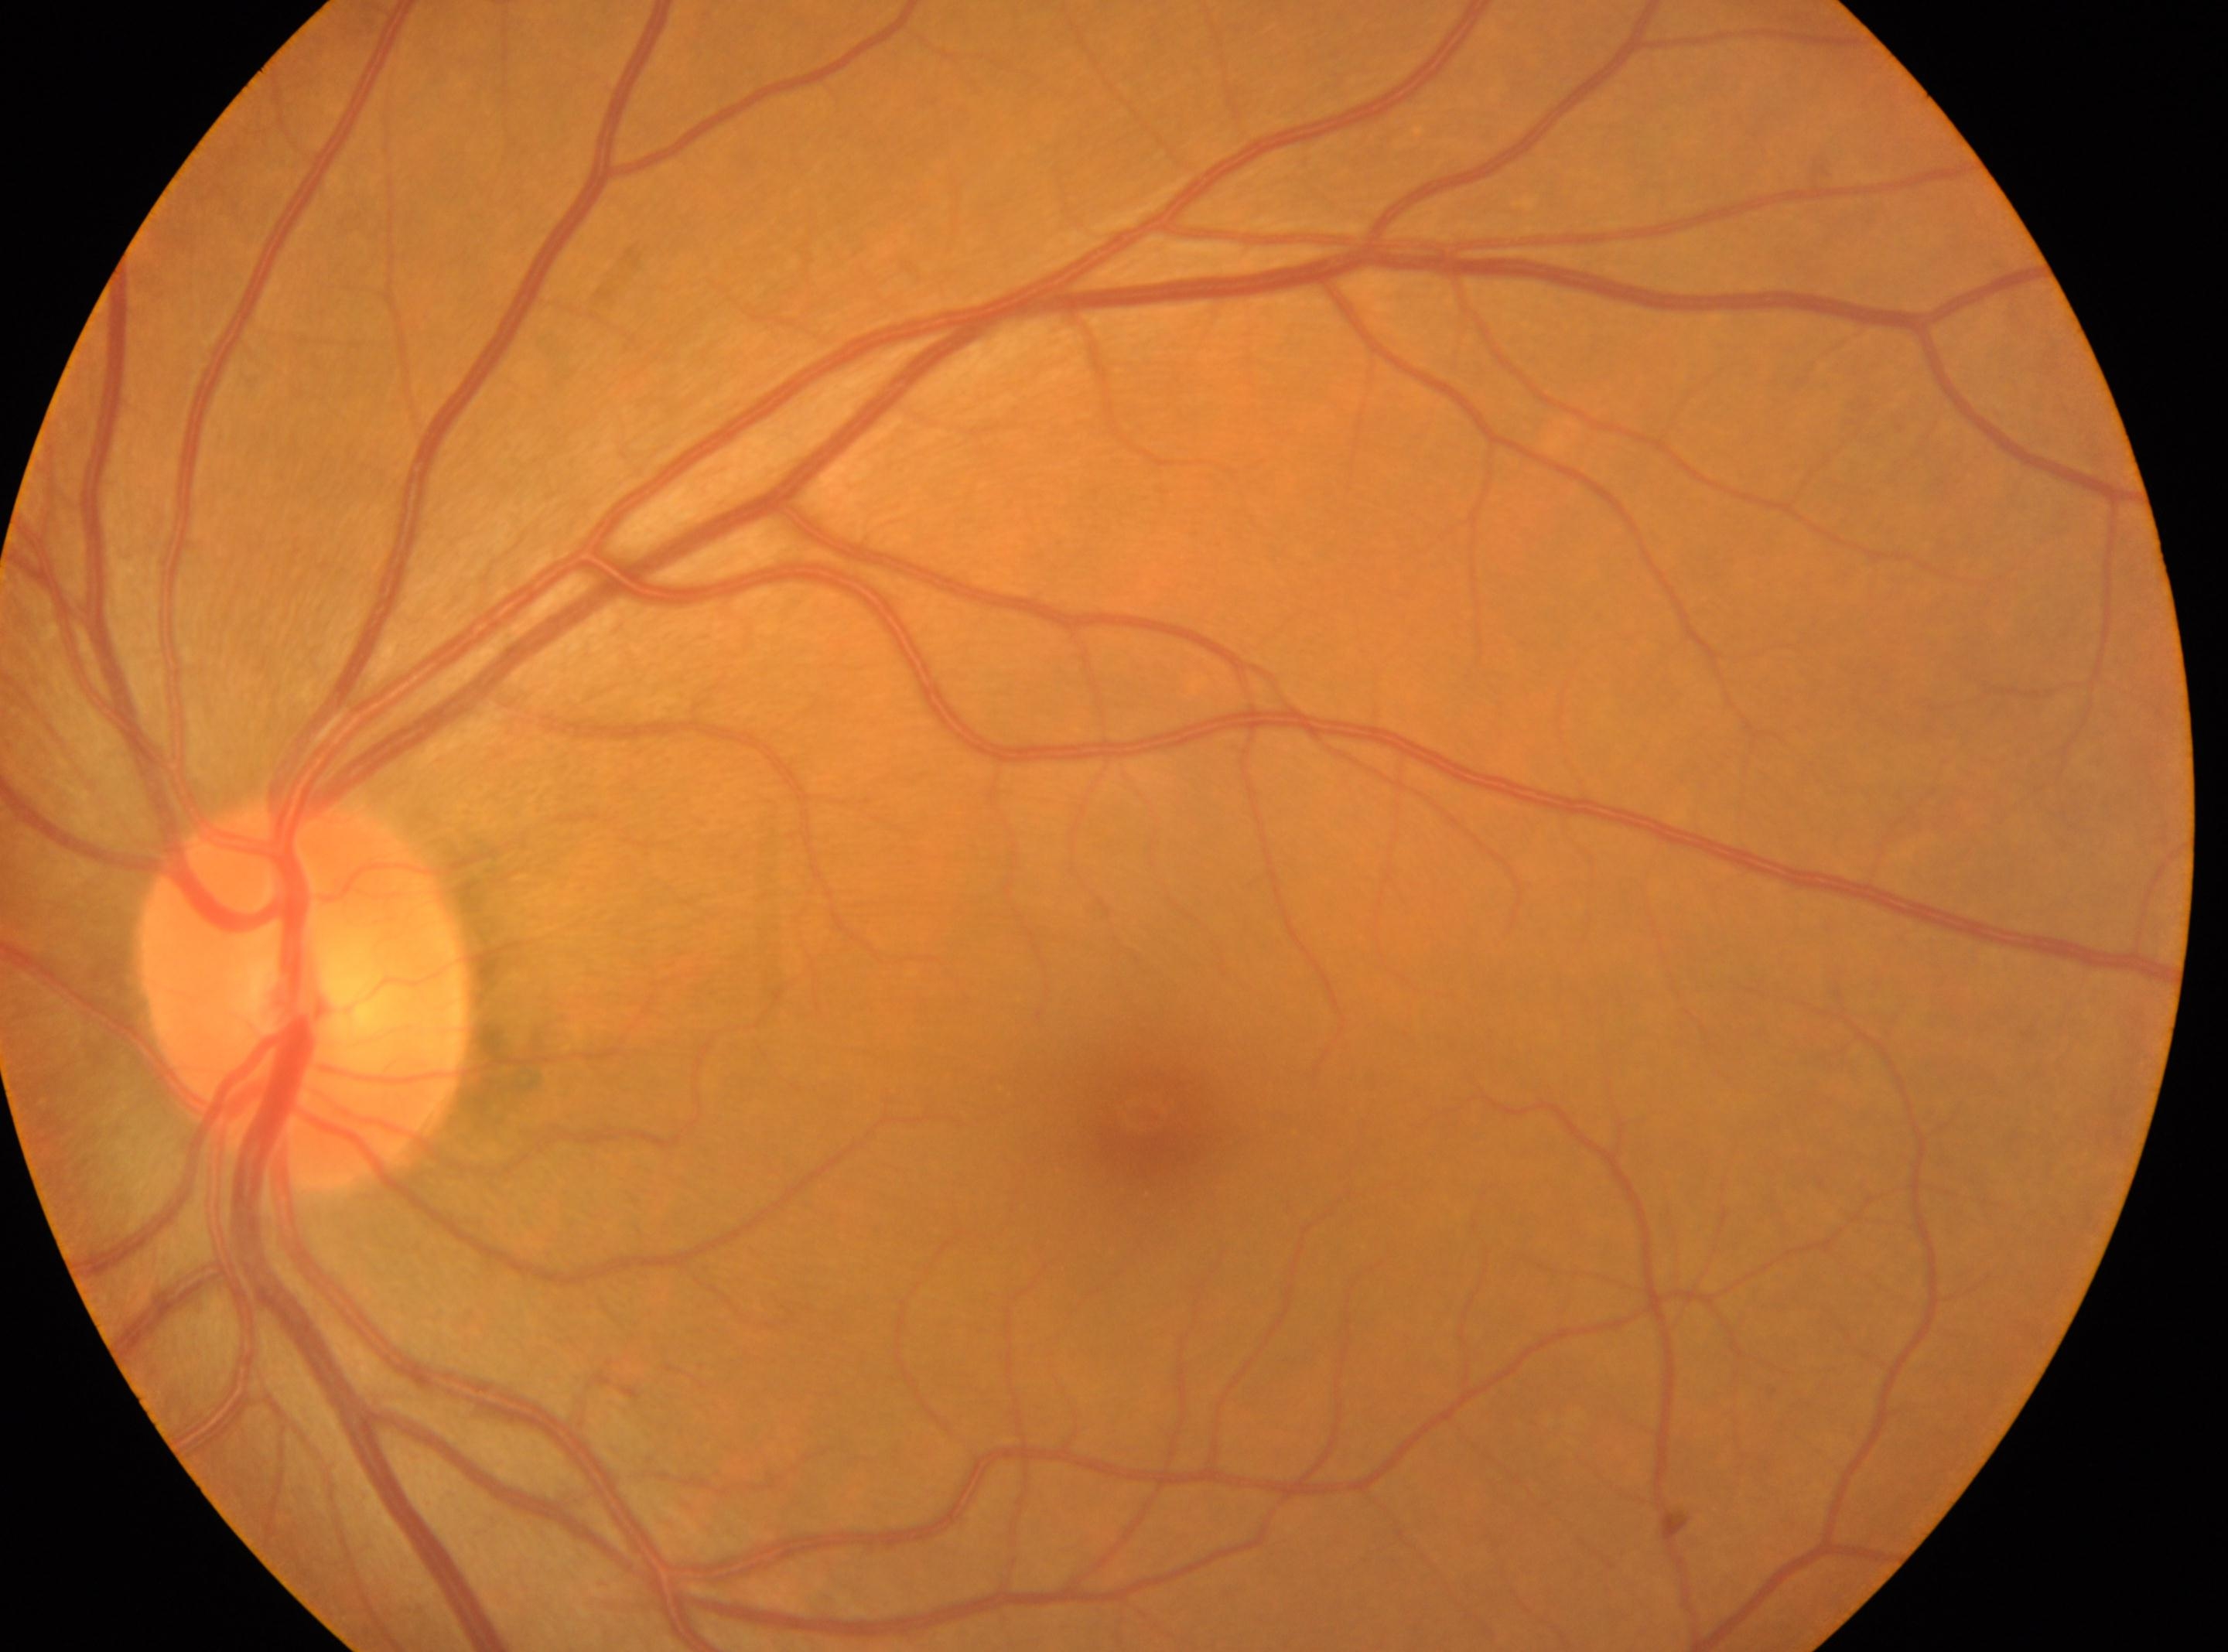
Eye: left eye. Diabetic retinopathy severity is grade 0 (no apparent retinopathy). The fovea centralis is at (x: 1139, y: 1114). Optic disk: (x: 304, y: 995). No apparent diabetic retinopathy.